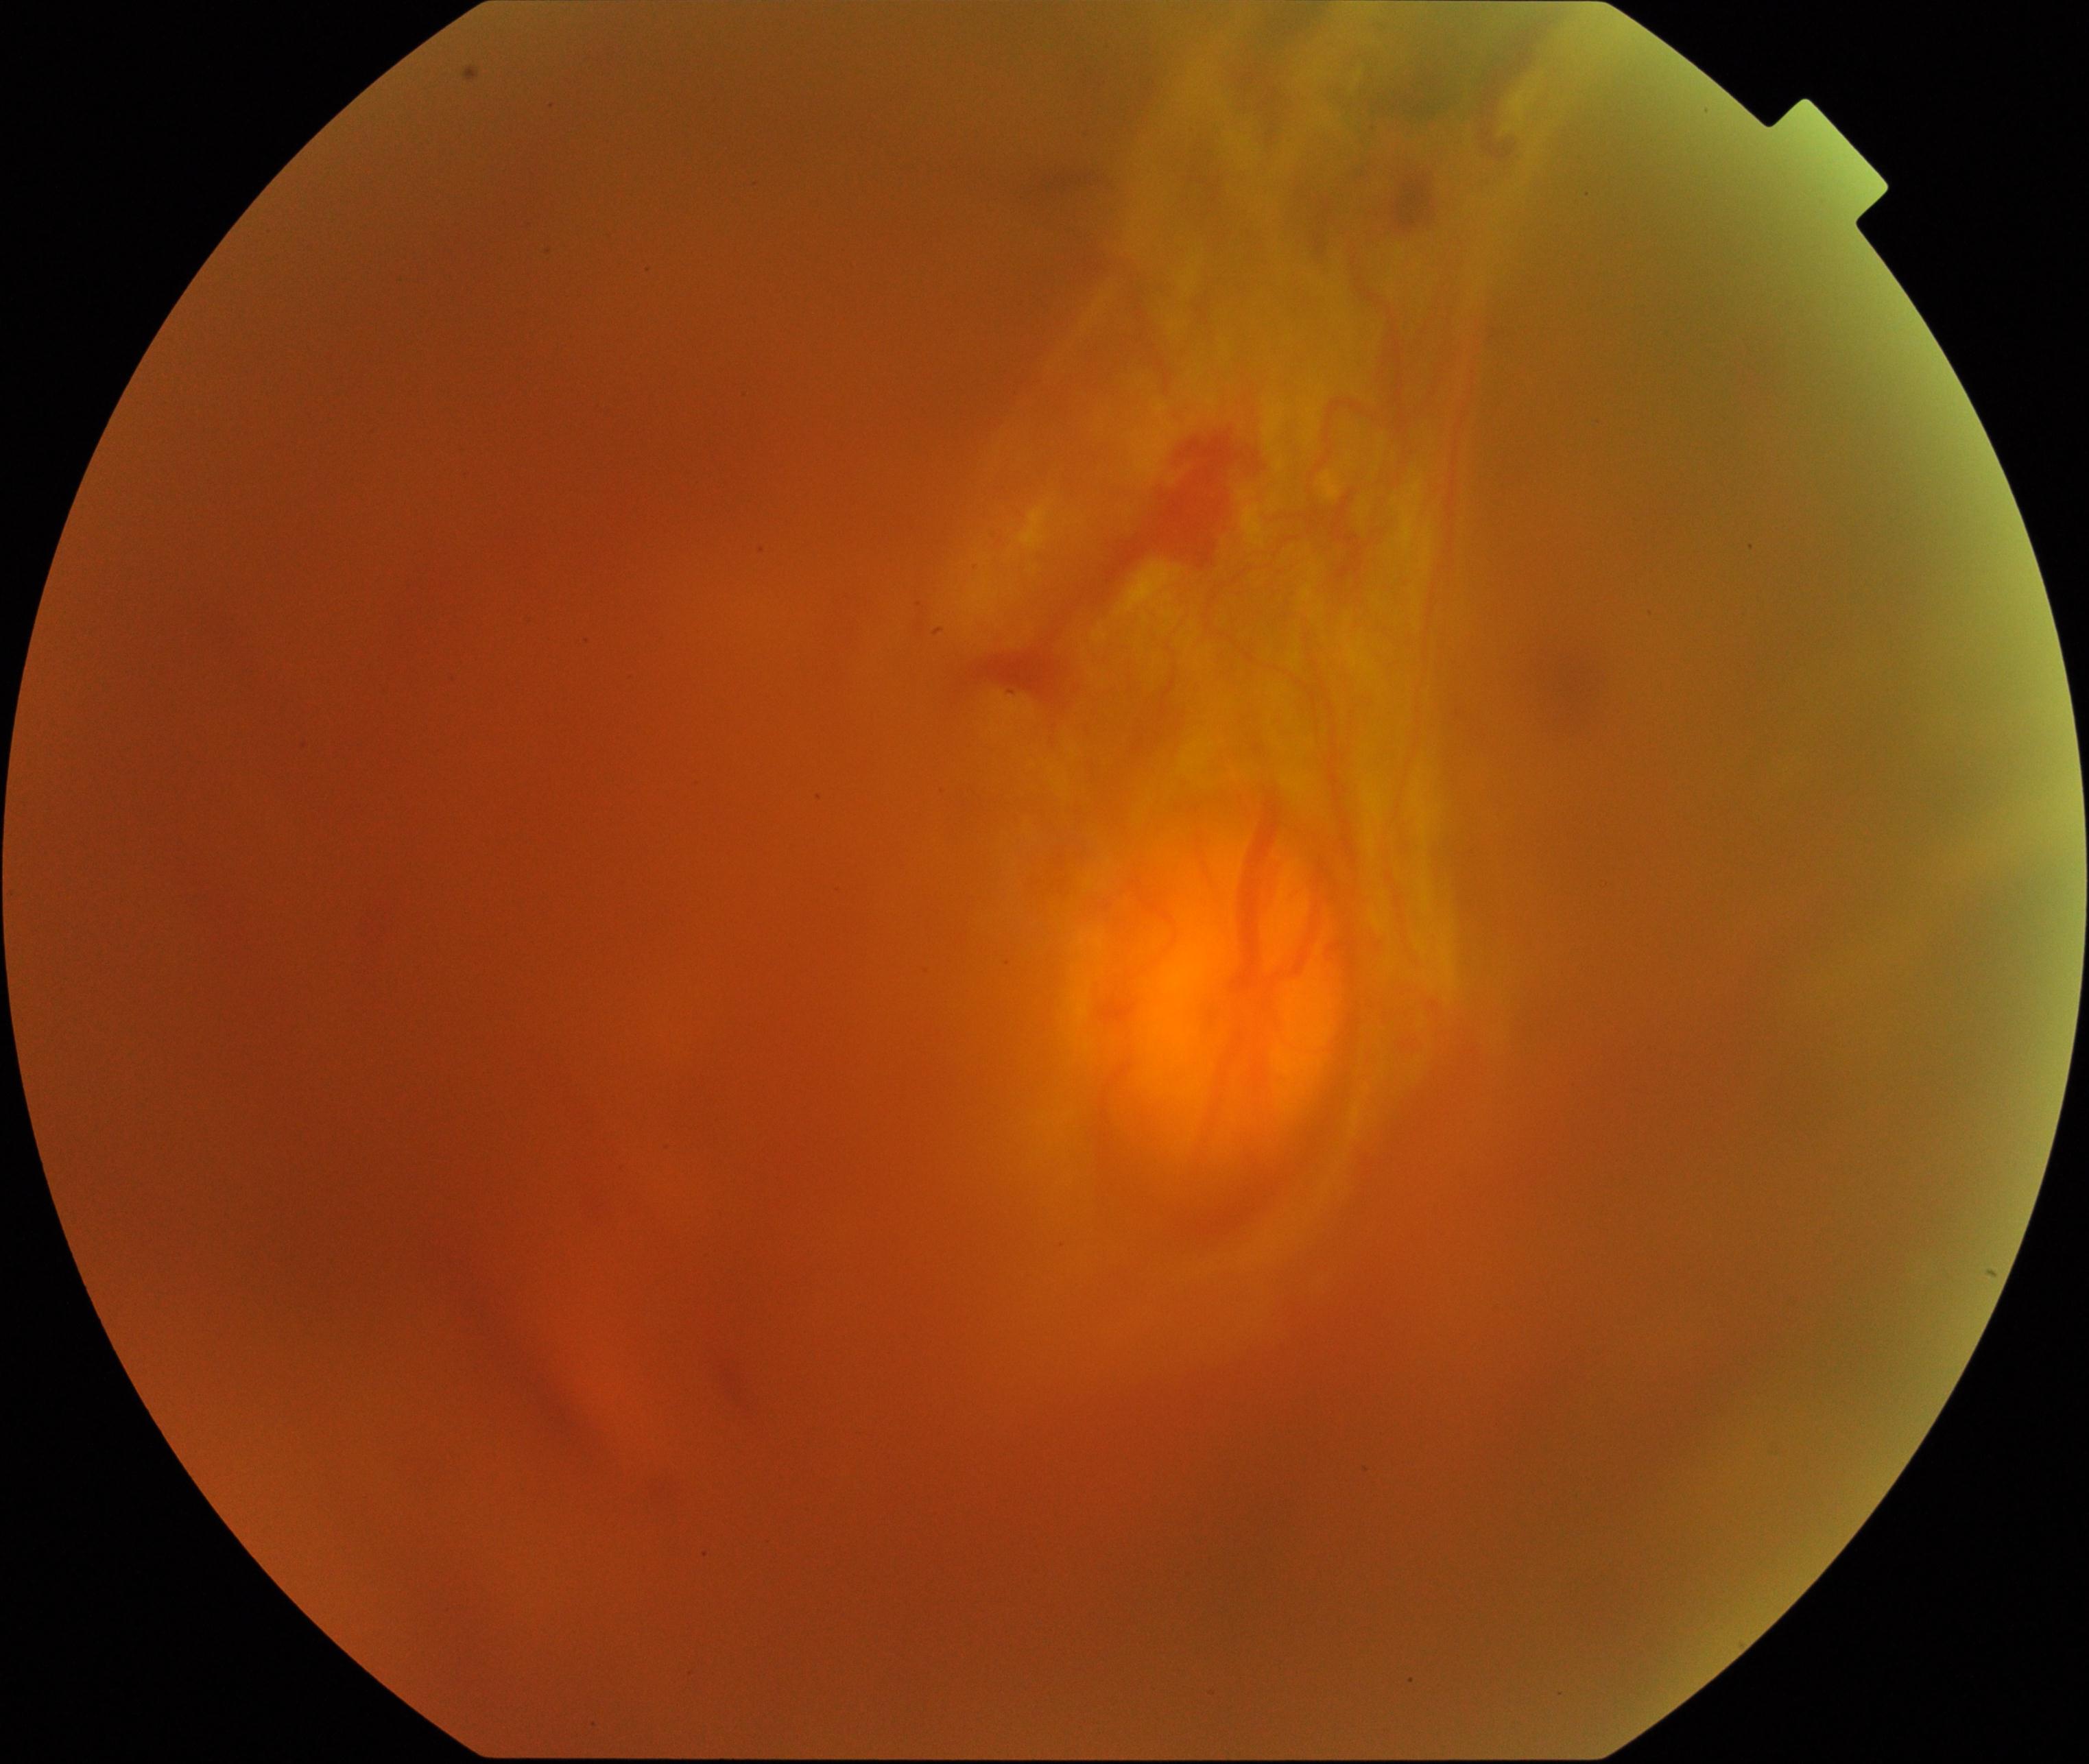
Significantly degraded image quality with obscured retinal detail. Features suspicious for proliferative diabetic retinopathy.